45° field of view; color fundus image.
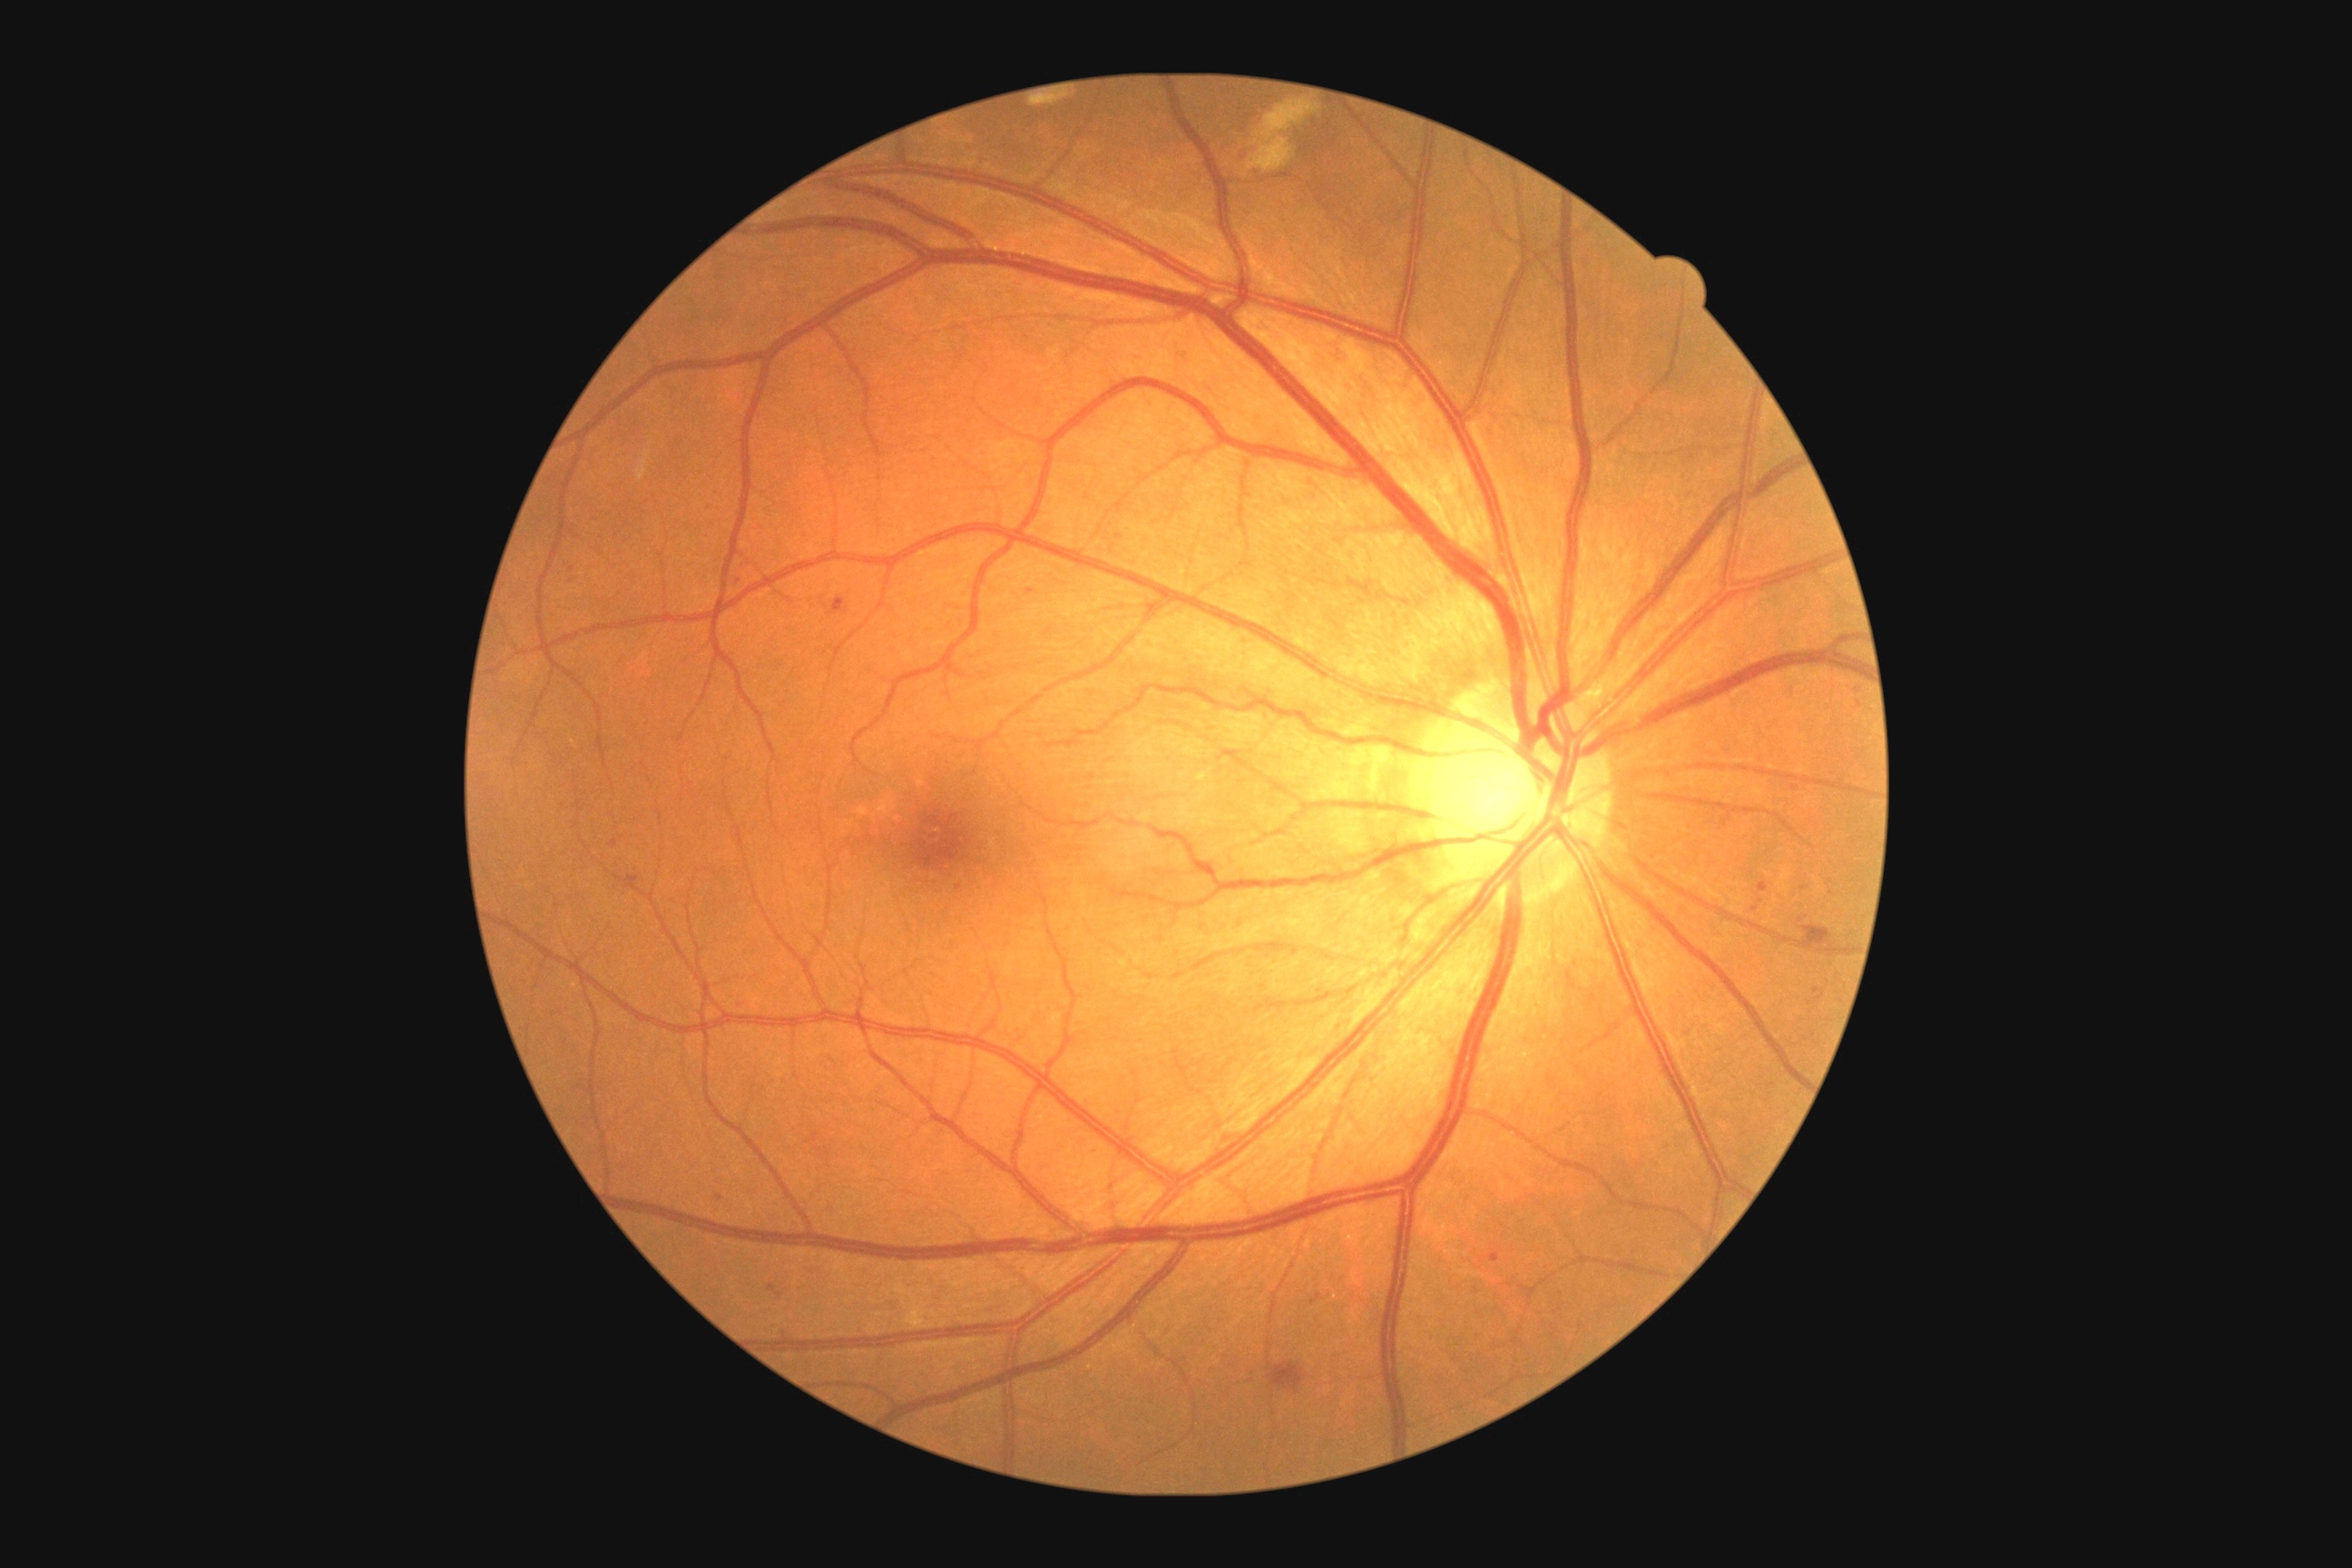

DR is grade 2 (moderate NPDR).
MAs are located at {"x1": 611, "y1": 839, "x2": 618, "y2": 848} | {"x1": 1026, "y1": 591, "x2": 1035, "y2": 594} | {"x1": 1814, "y1": 986, "x2": 1825, "y2": 1001} | {"x1": 1311, "y1": 1293, "x2": 1324, "y2": 1306} | {"x1": 1489, "y1": 1253, "x2": 1500, "y2": 1262} | {"x1": 1758, "y1": 883, "x2": 1769, "y2": 892} | {"x1": 625, "y1": 876, "x2": 640, "y2": 890} | {"x1": 769, "y1": 1286, "x2": 783, "y2": 1298} | {"x1": 830, "y1": 598, "x2": 848, "y2": 614}.
Smaller MAs around [x=573, y=570] | [x=959, y=887] | [x=1801, y=920] | [x=739, y=581] | [x=1756, y=910] | [x=720, y=1197] | [x=1761, y=901].
HEs are located at {"x1": 1799, "y1": 926, "x2": 1832, "y2": 950} | {"x1": 1269, "y1": 1364, "x2": 1306, "y2": 1391}.
No EXs identified.
SEs are located at {"x1": 1248, "y1": 99, "x2": 1322, "y2": 173}.